Wide-field fundus photograph from neonatal ROP screening. Clarity RetCam 3, 130° FOV:
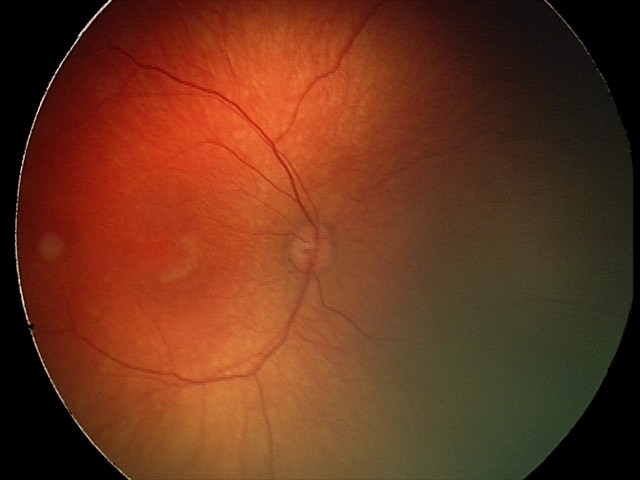
Normal screening examination.